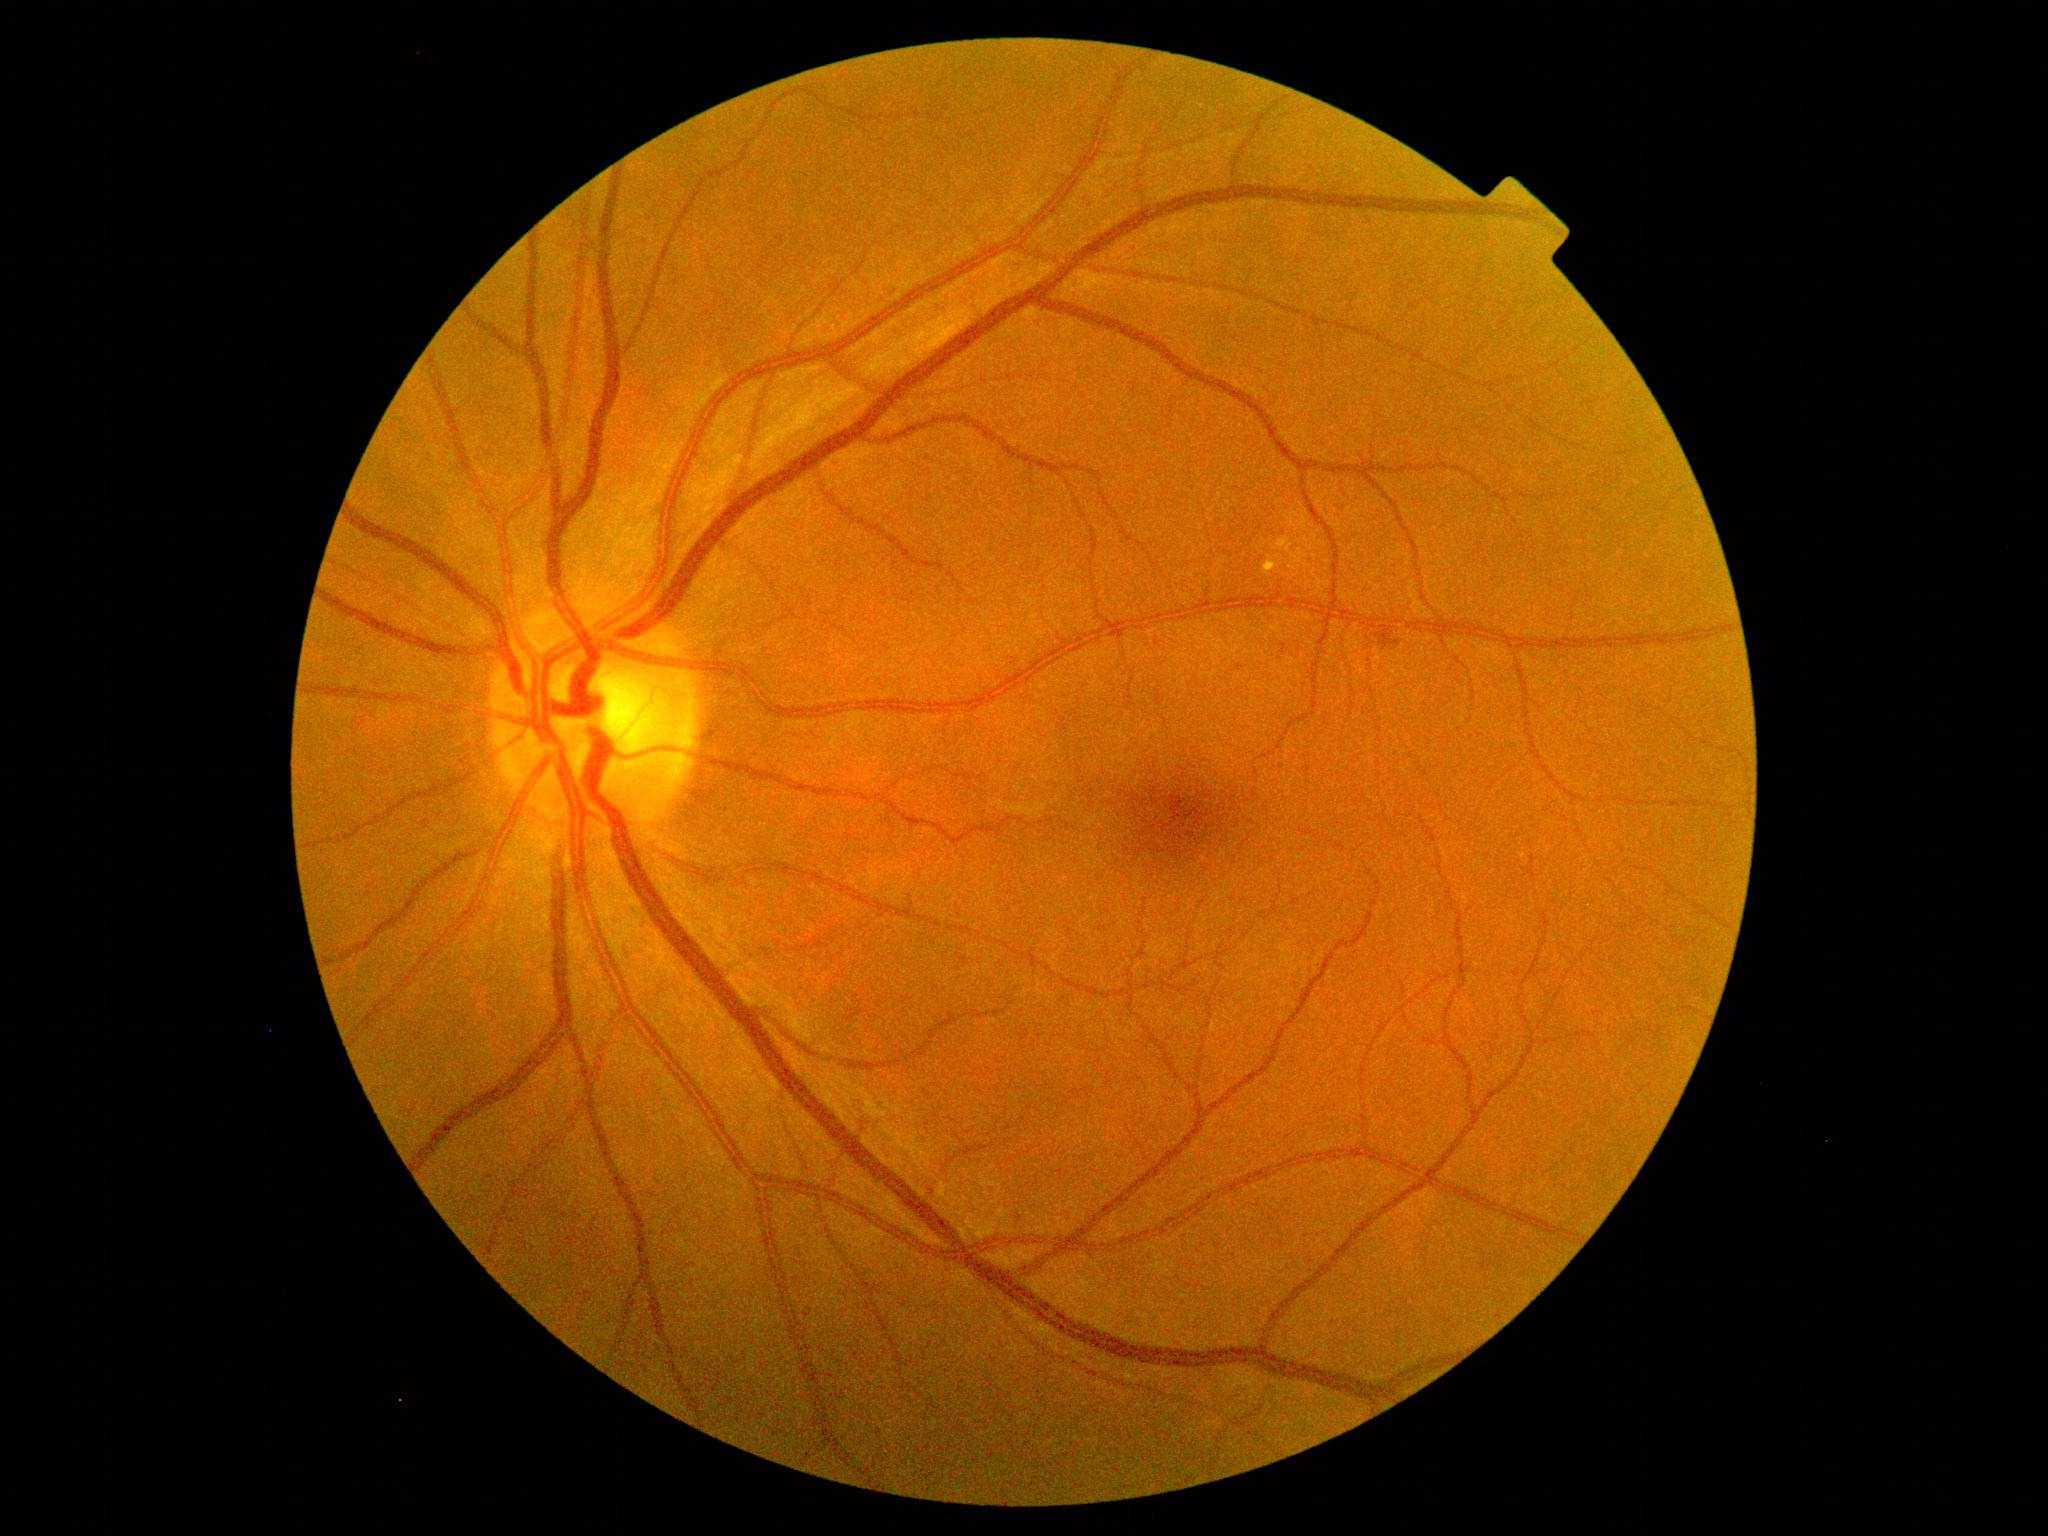
{"partial":true,"dr_grade":2,"dr_grade_name":"moderate NPDR","lesions":{"ma":null,"ex":[[1264,556,1281,576],[1277,540,1297,555]],"se":null,"he":[[1337,483,1350,512],[1376,626,1401,651],[1278,642,1297,658]],"he_small_centers":[[1240,668]]}}